45° FOV · 2212 x 1659 pixels.
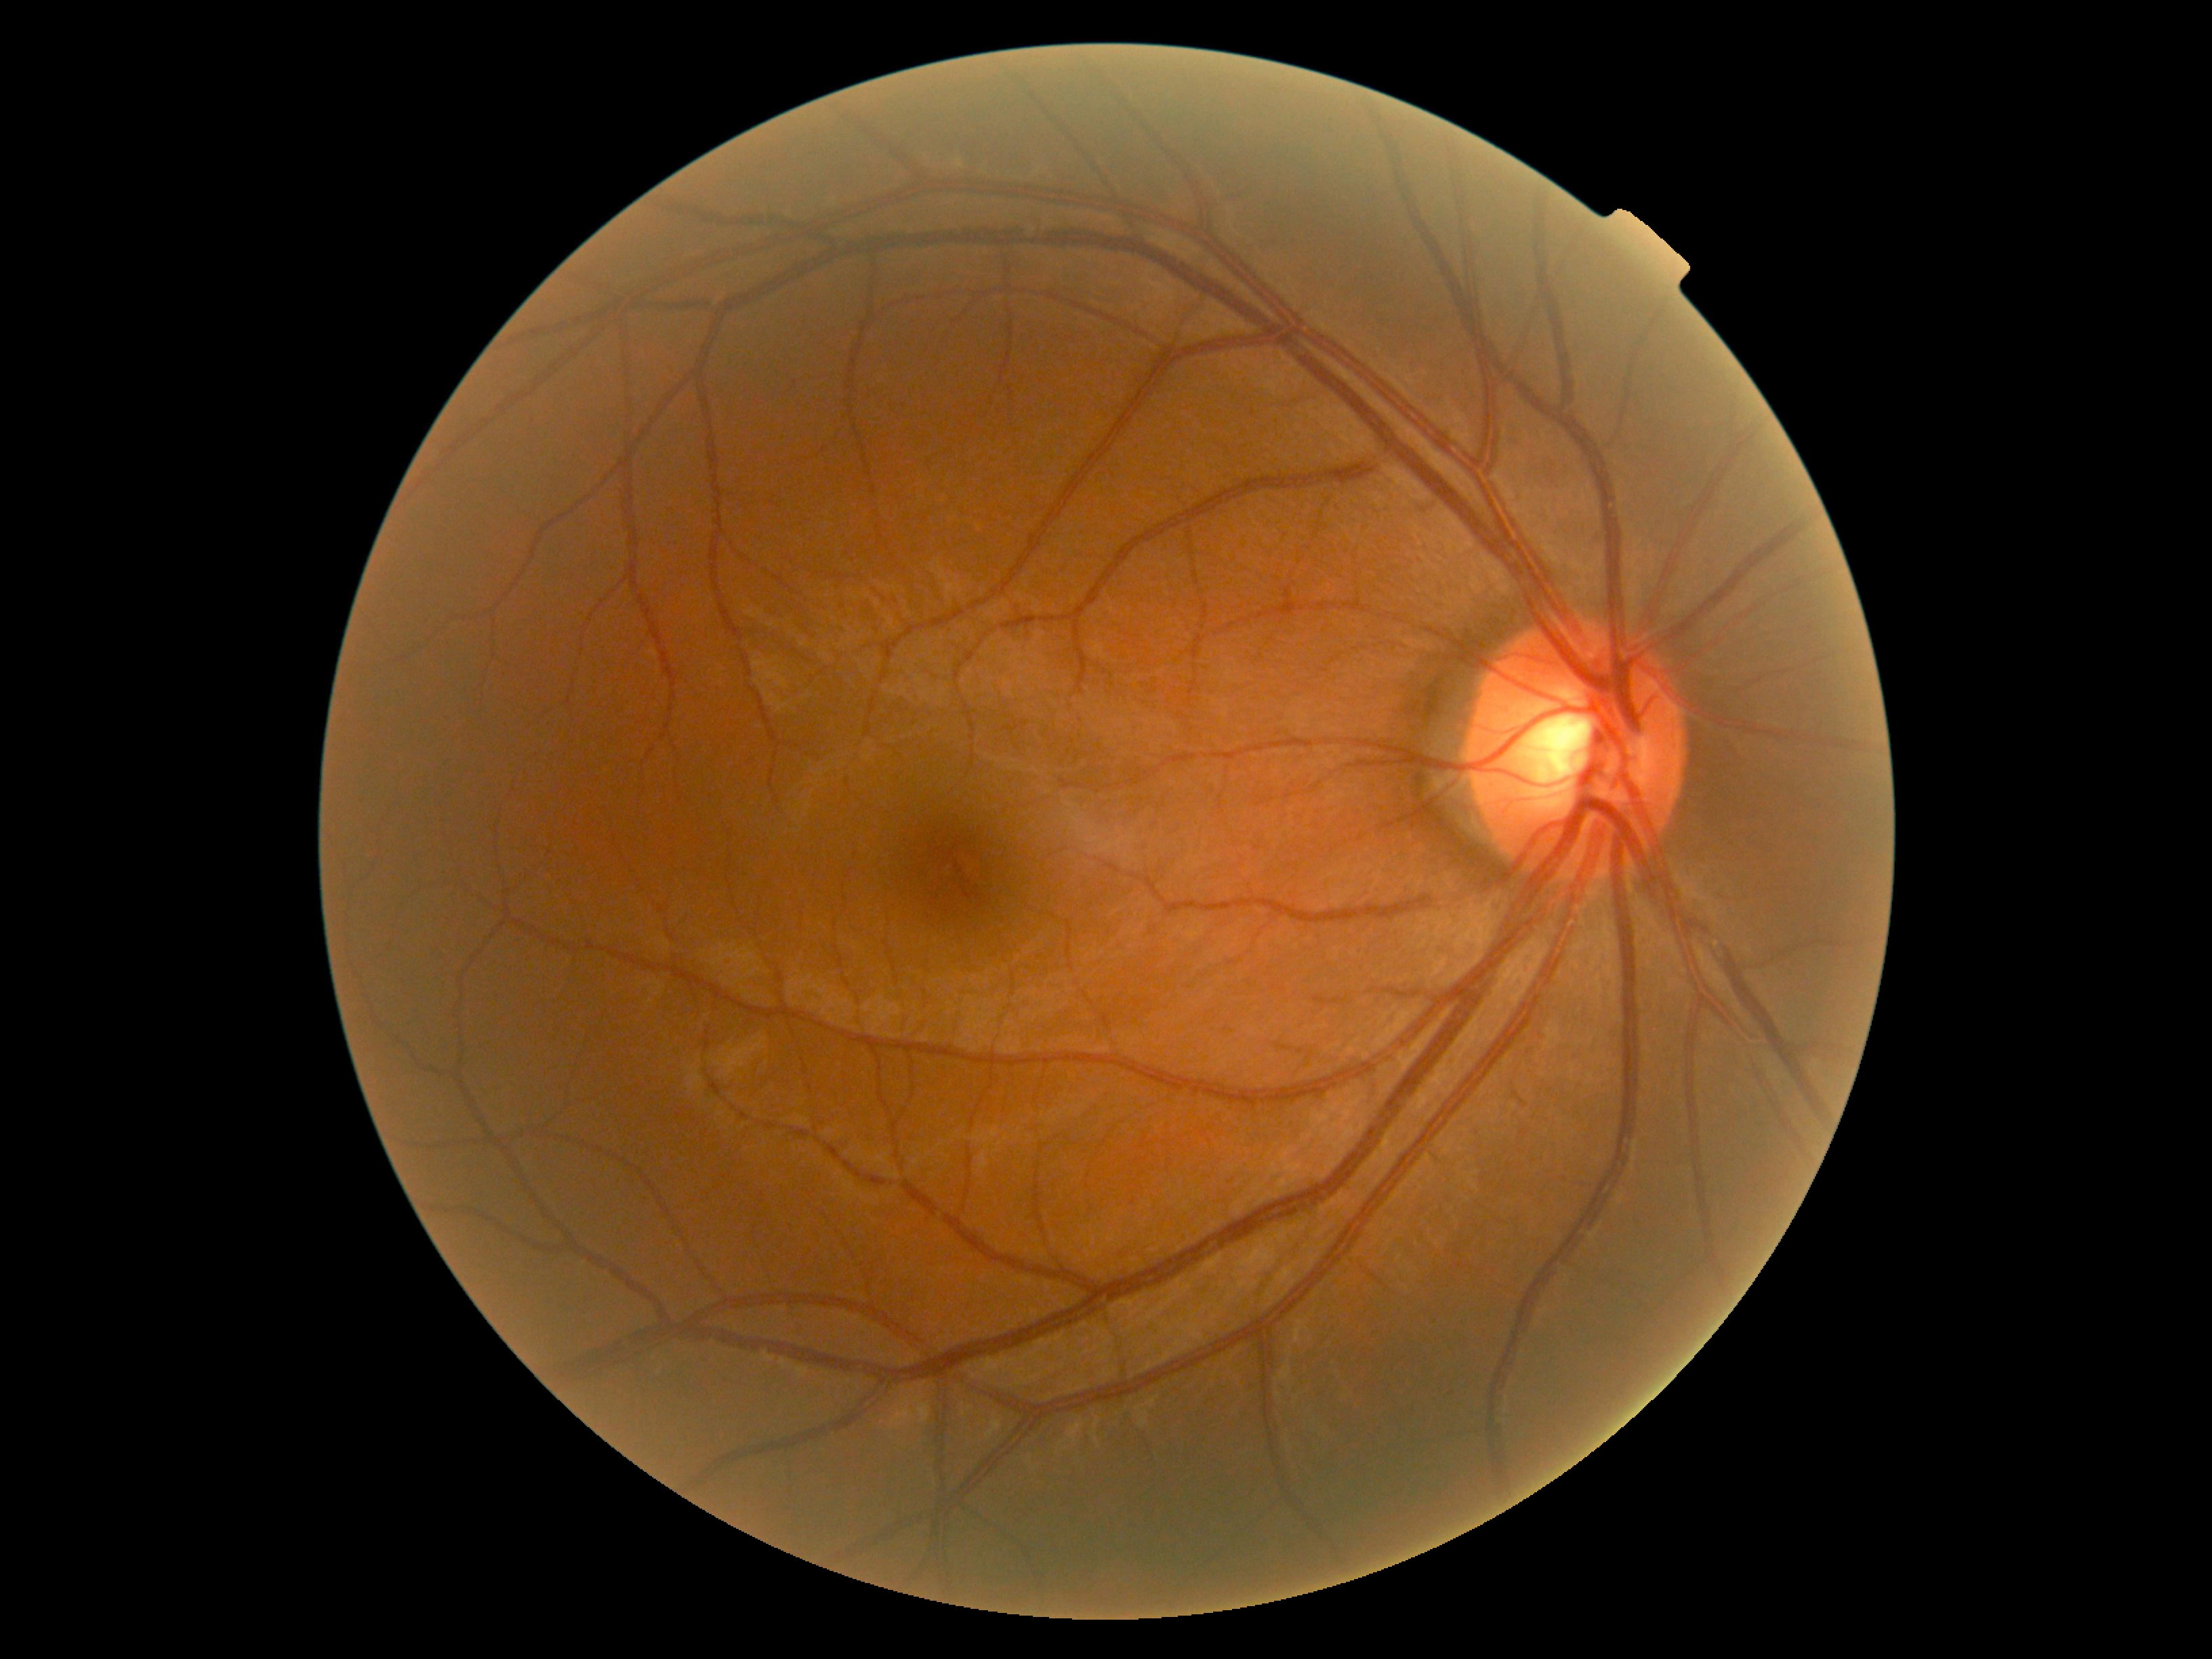
Annotations:
– retinopathy: grade 0 (no apparent retinopathy)
– DR impression: no DR findings